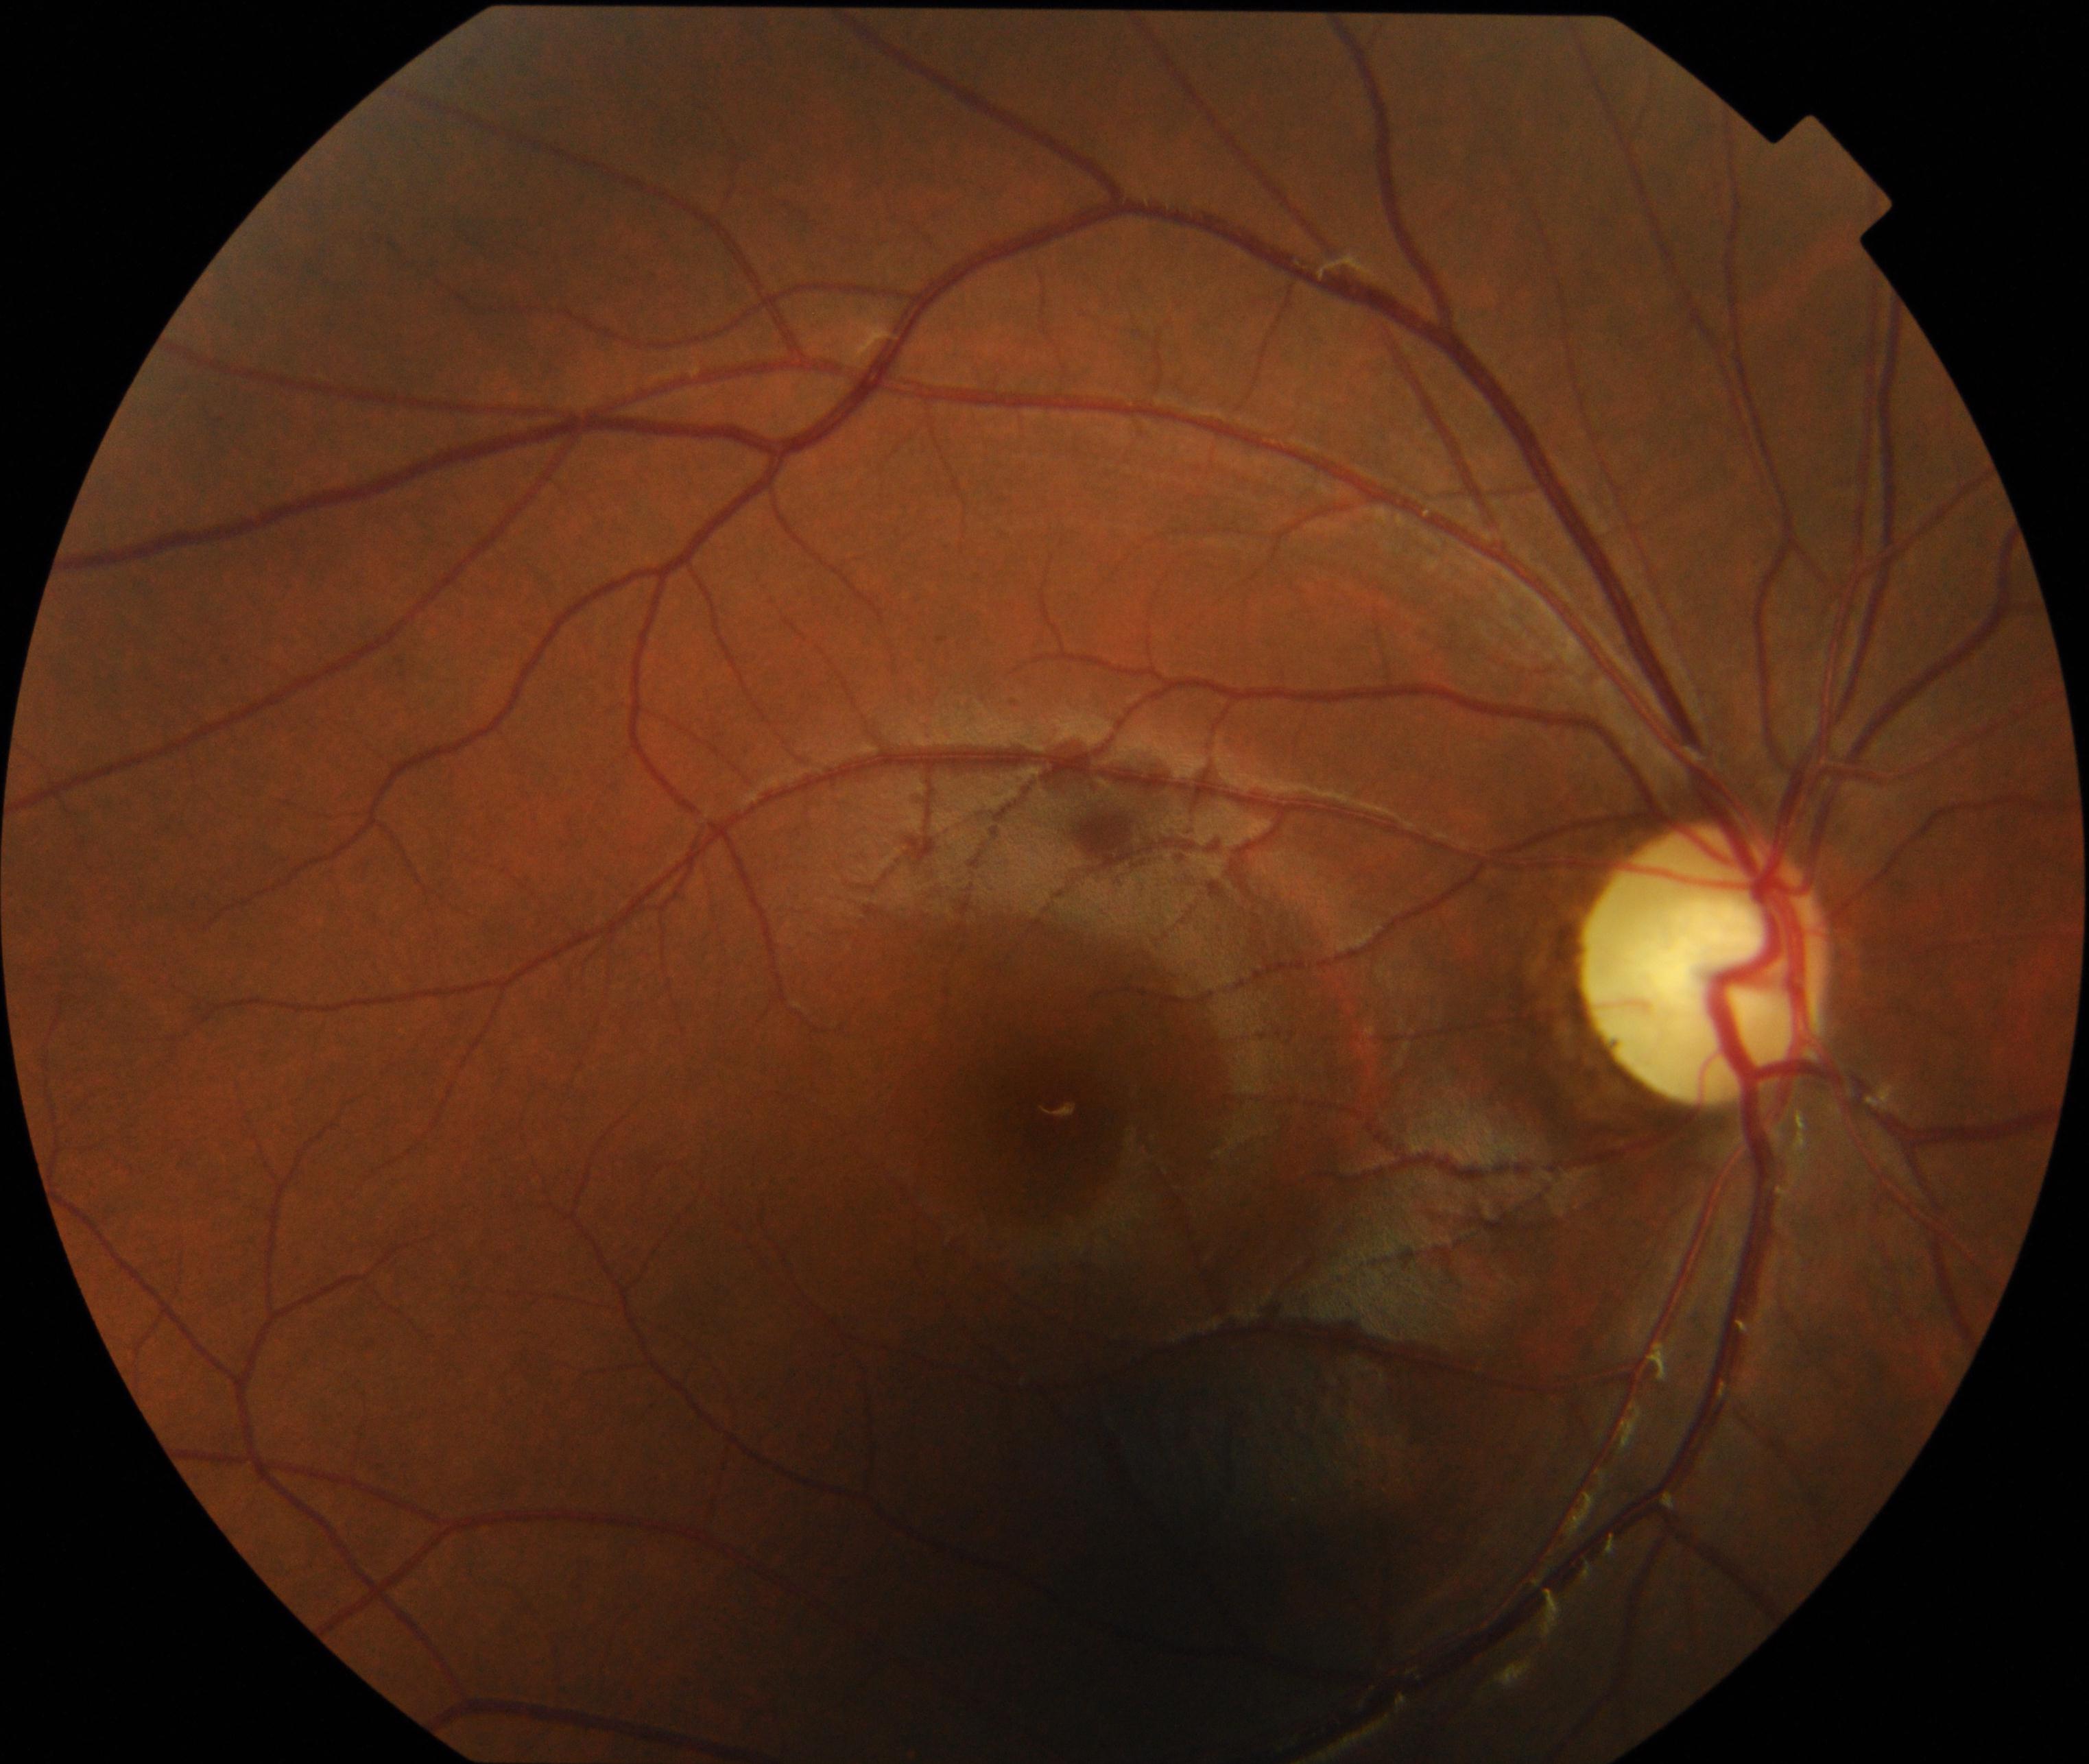
This fundus photograph shows optic atrophy.